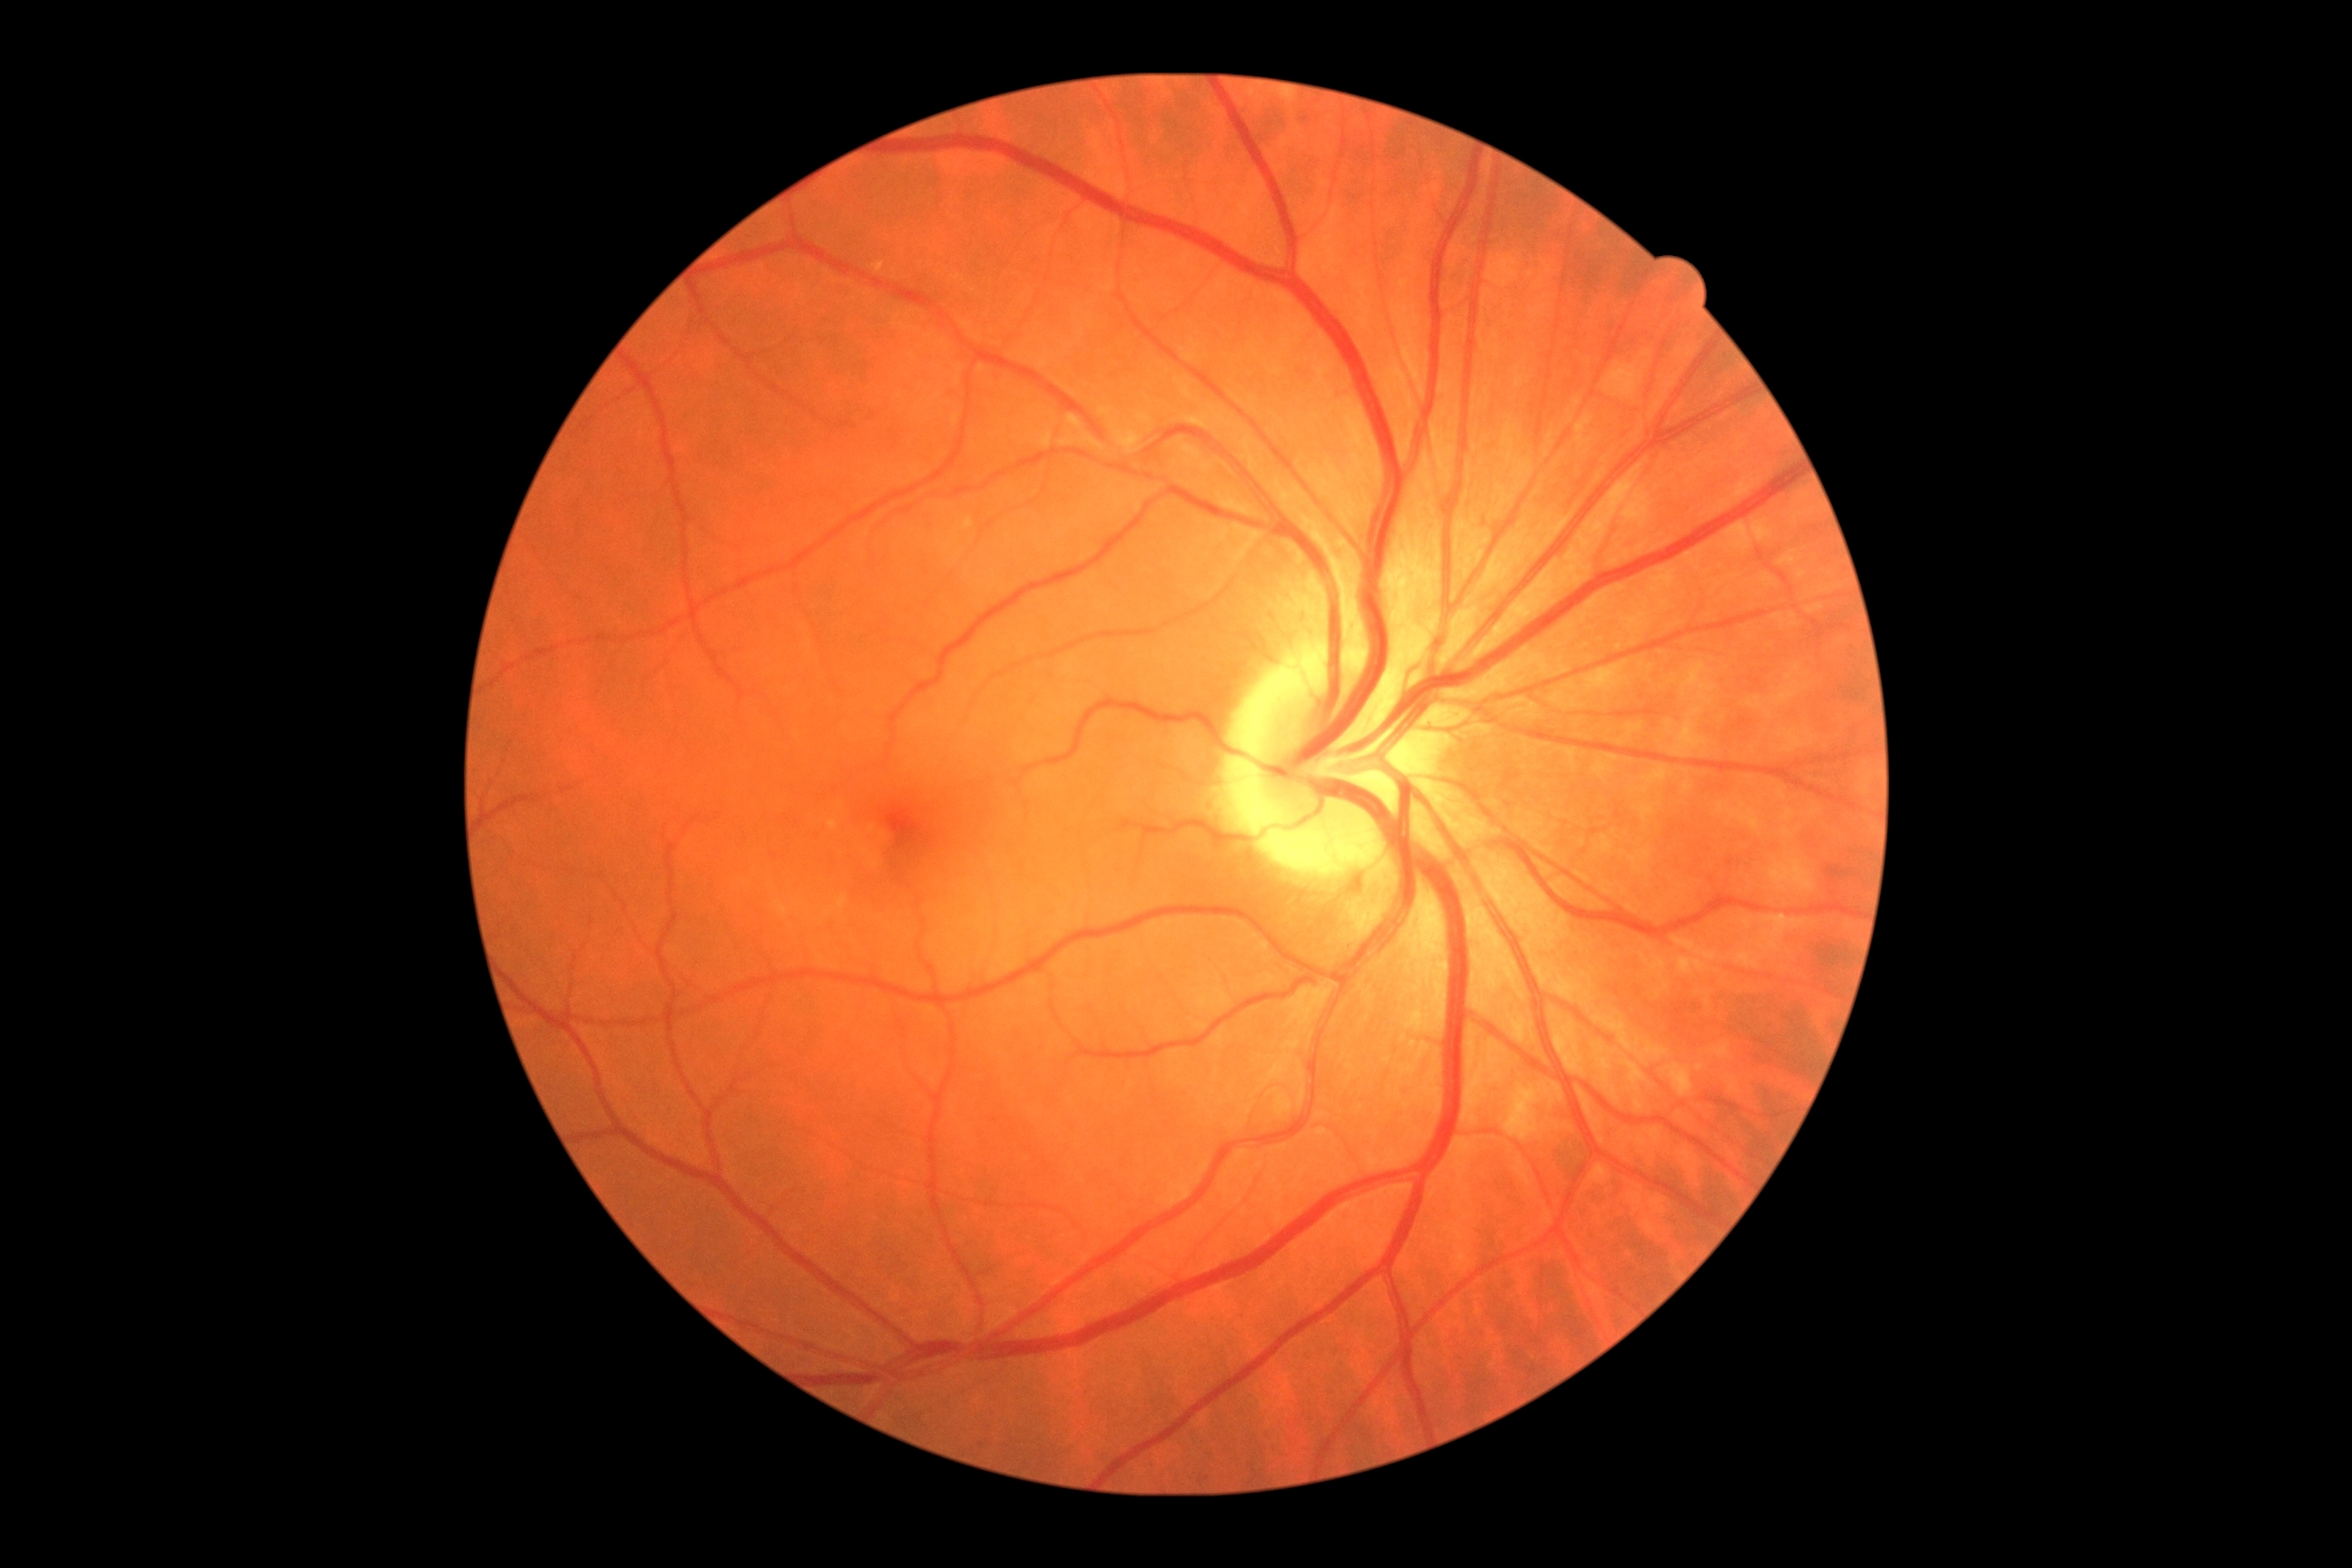
DR stage: 0